Wide-field fundus photograph of an infant:
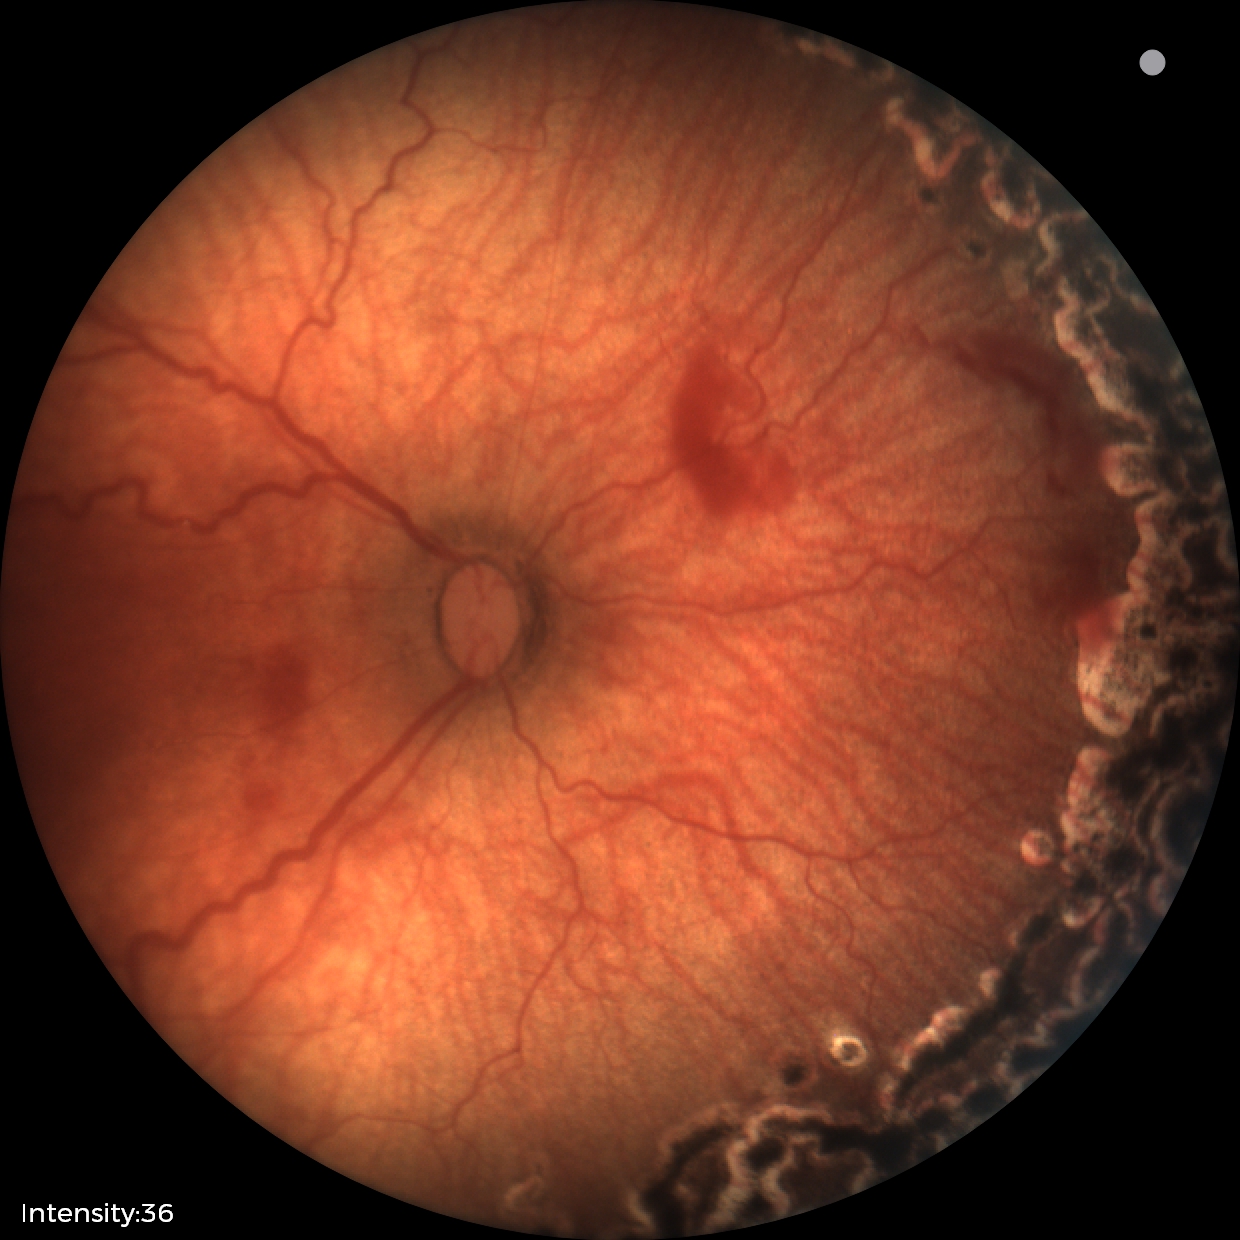
Screening series with status post ROP. Without plus disease.